Camera: NIDEK AFC-230, posterior pole photograph: 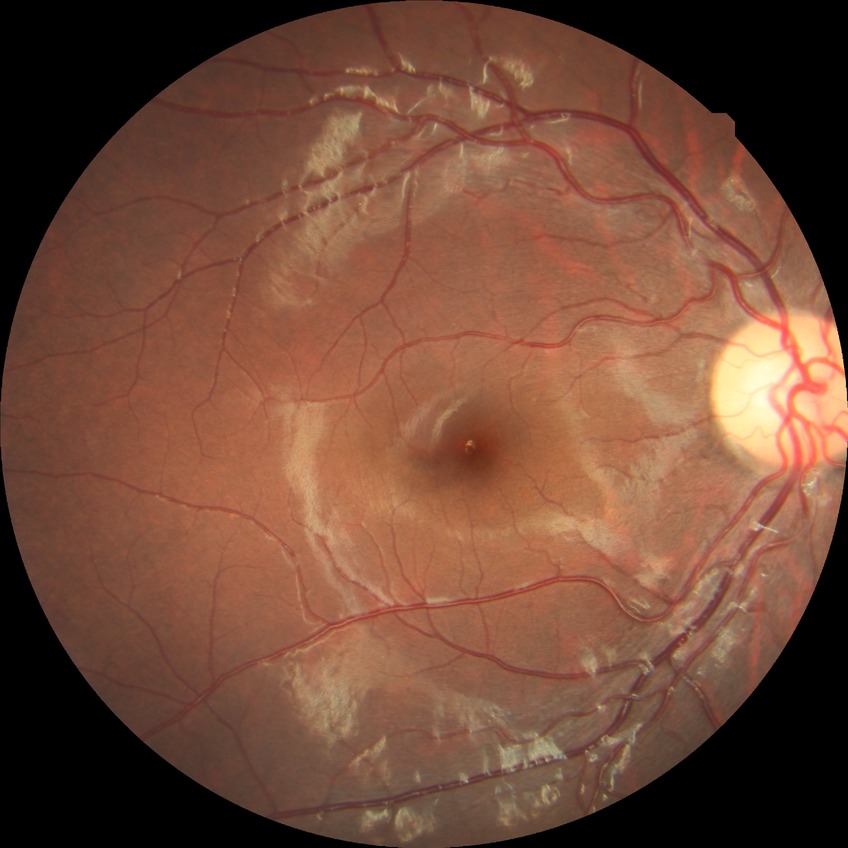

Retinopathy stage is no diabetic retinopathy.